DR severity per modified Davis staging
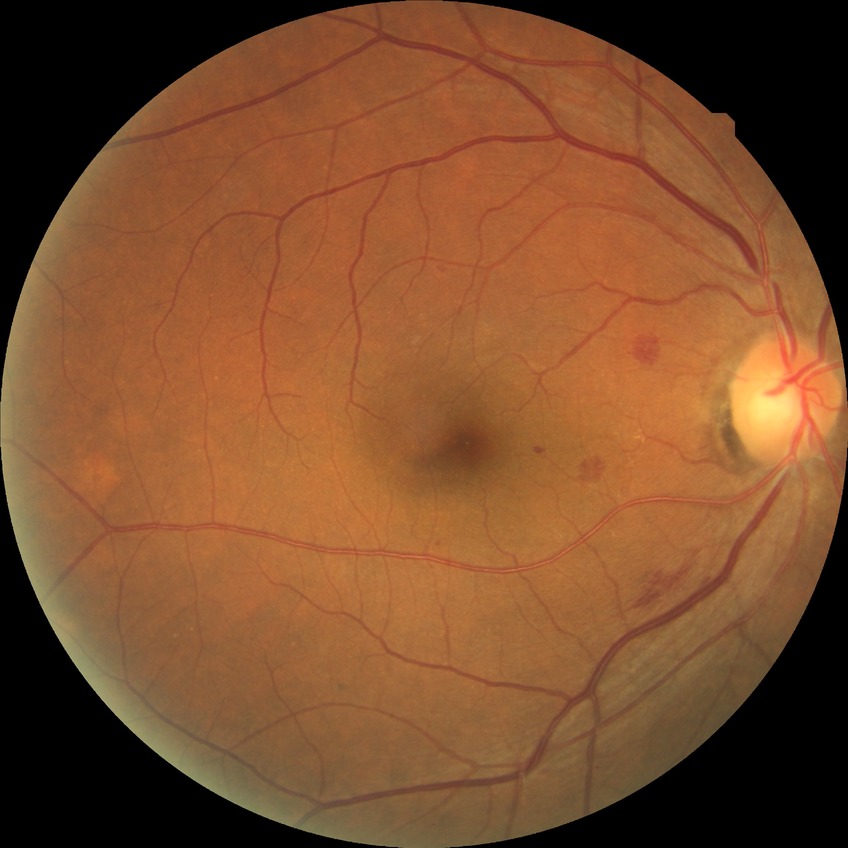
diabetic retinopathy (DR): SDR (simple diabetic retinopathy).